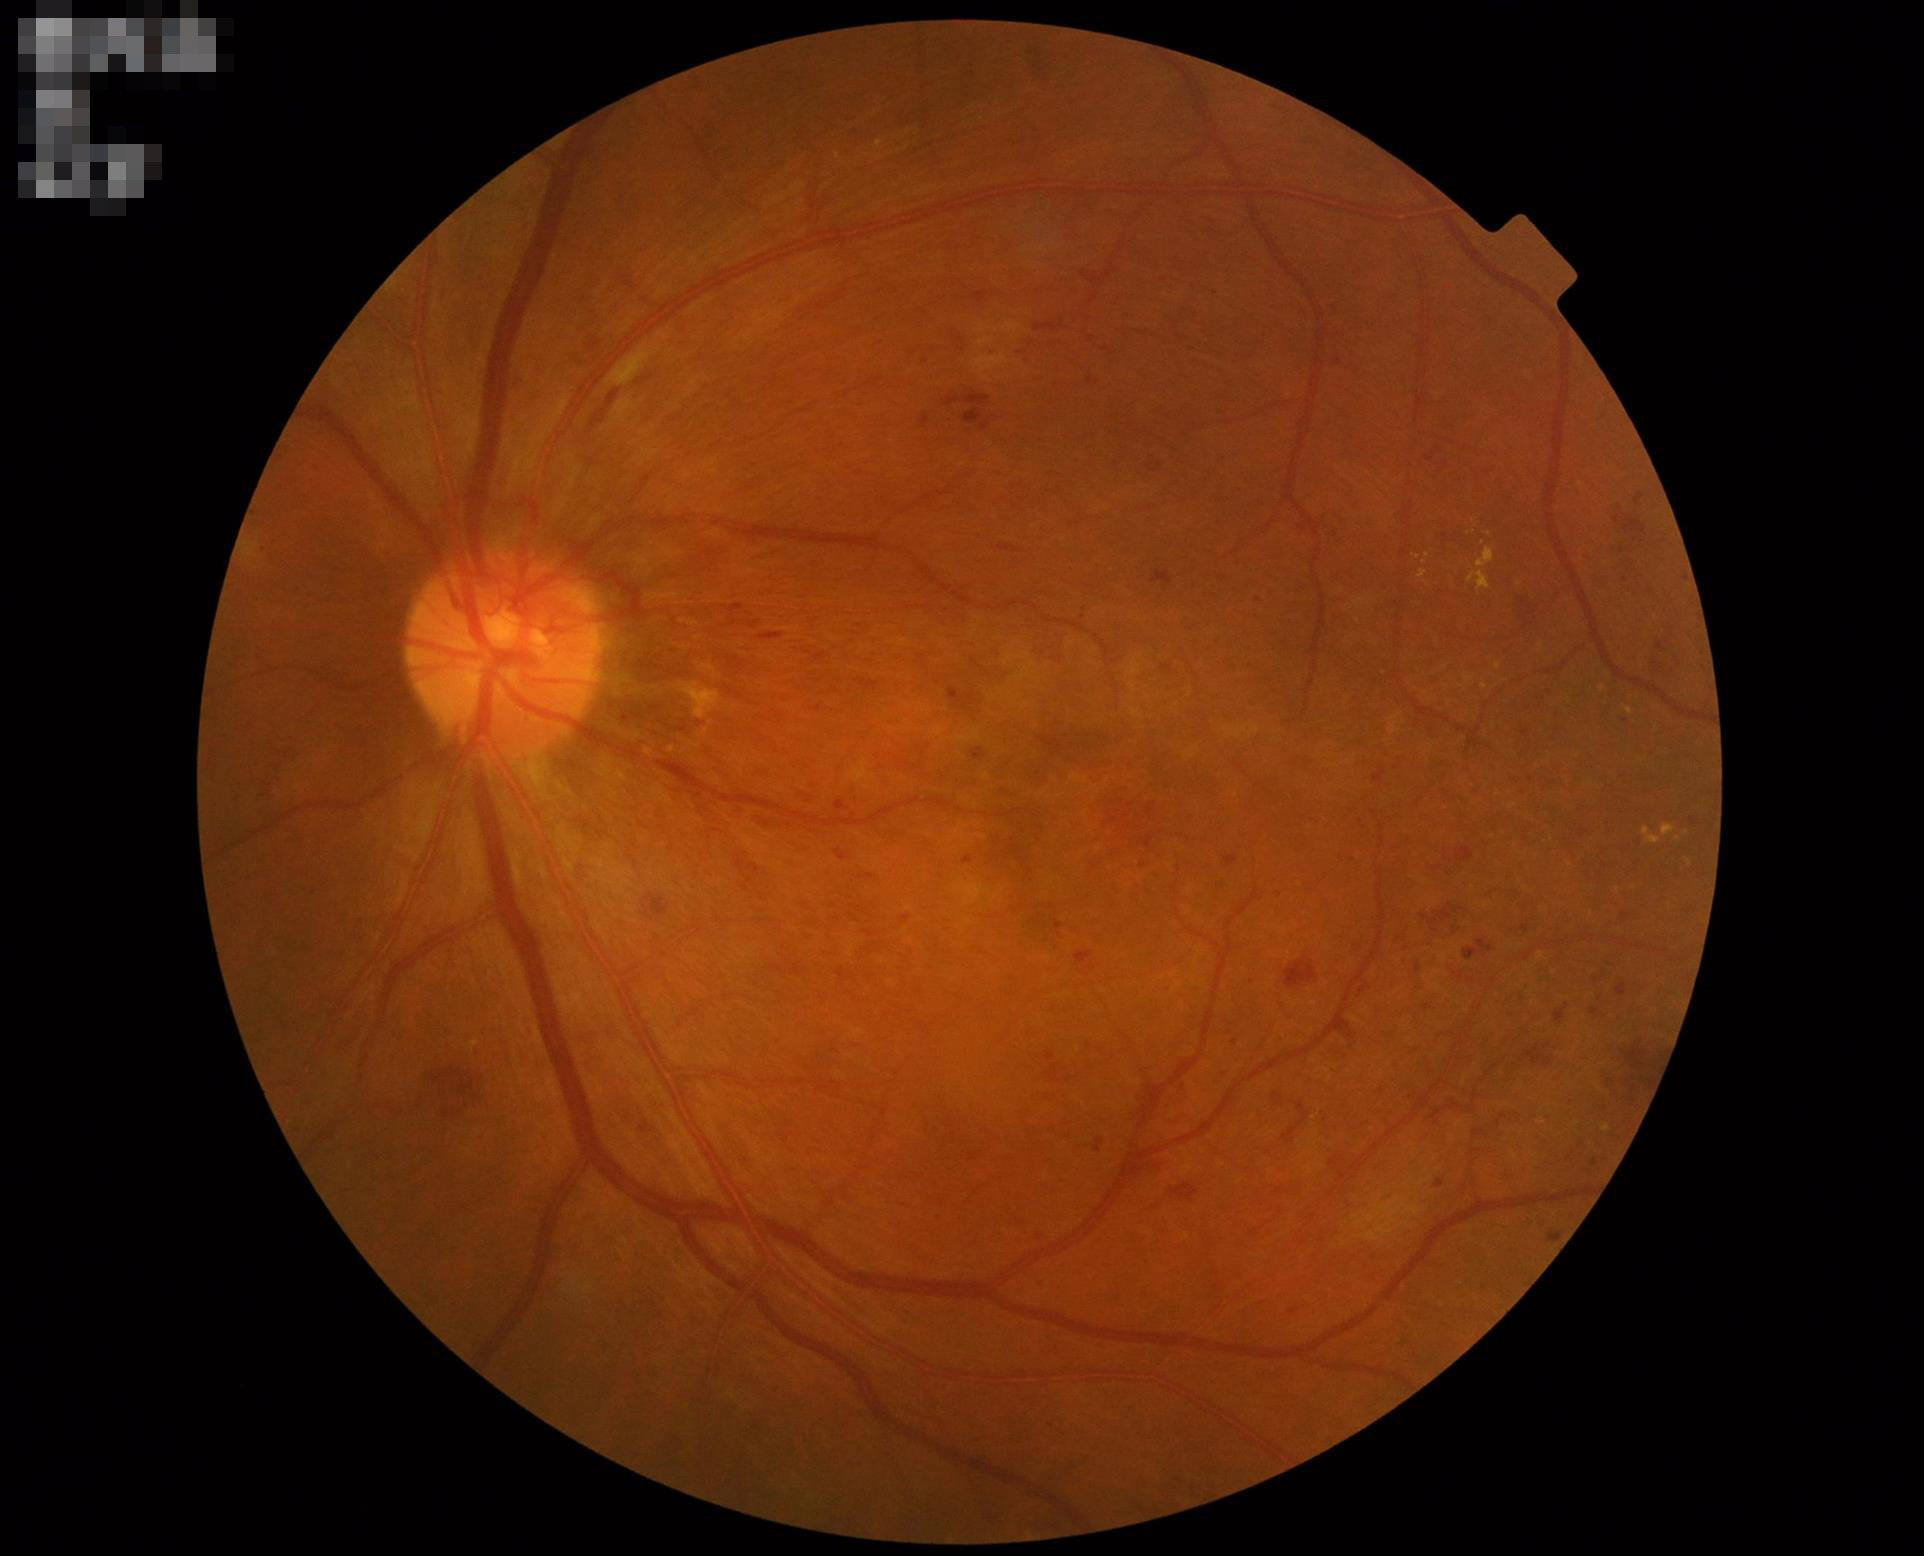 Overall quality is good and the image is gradable.
Image is sharp throughout the field.
Contrast is good.
Illumination is even.